45-degree field of view: 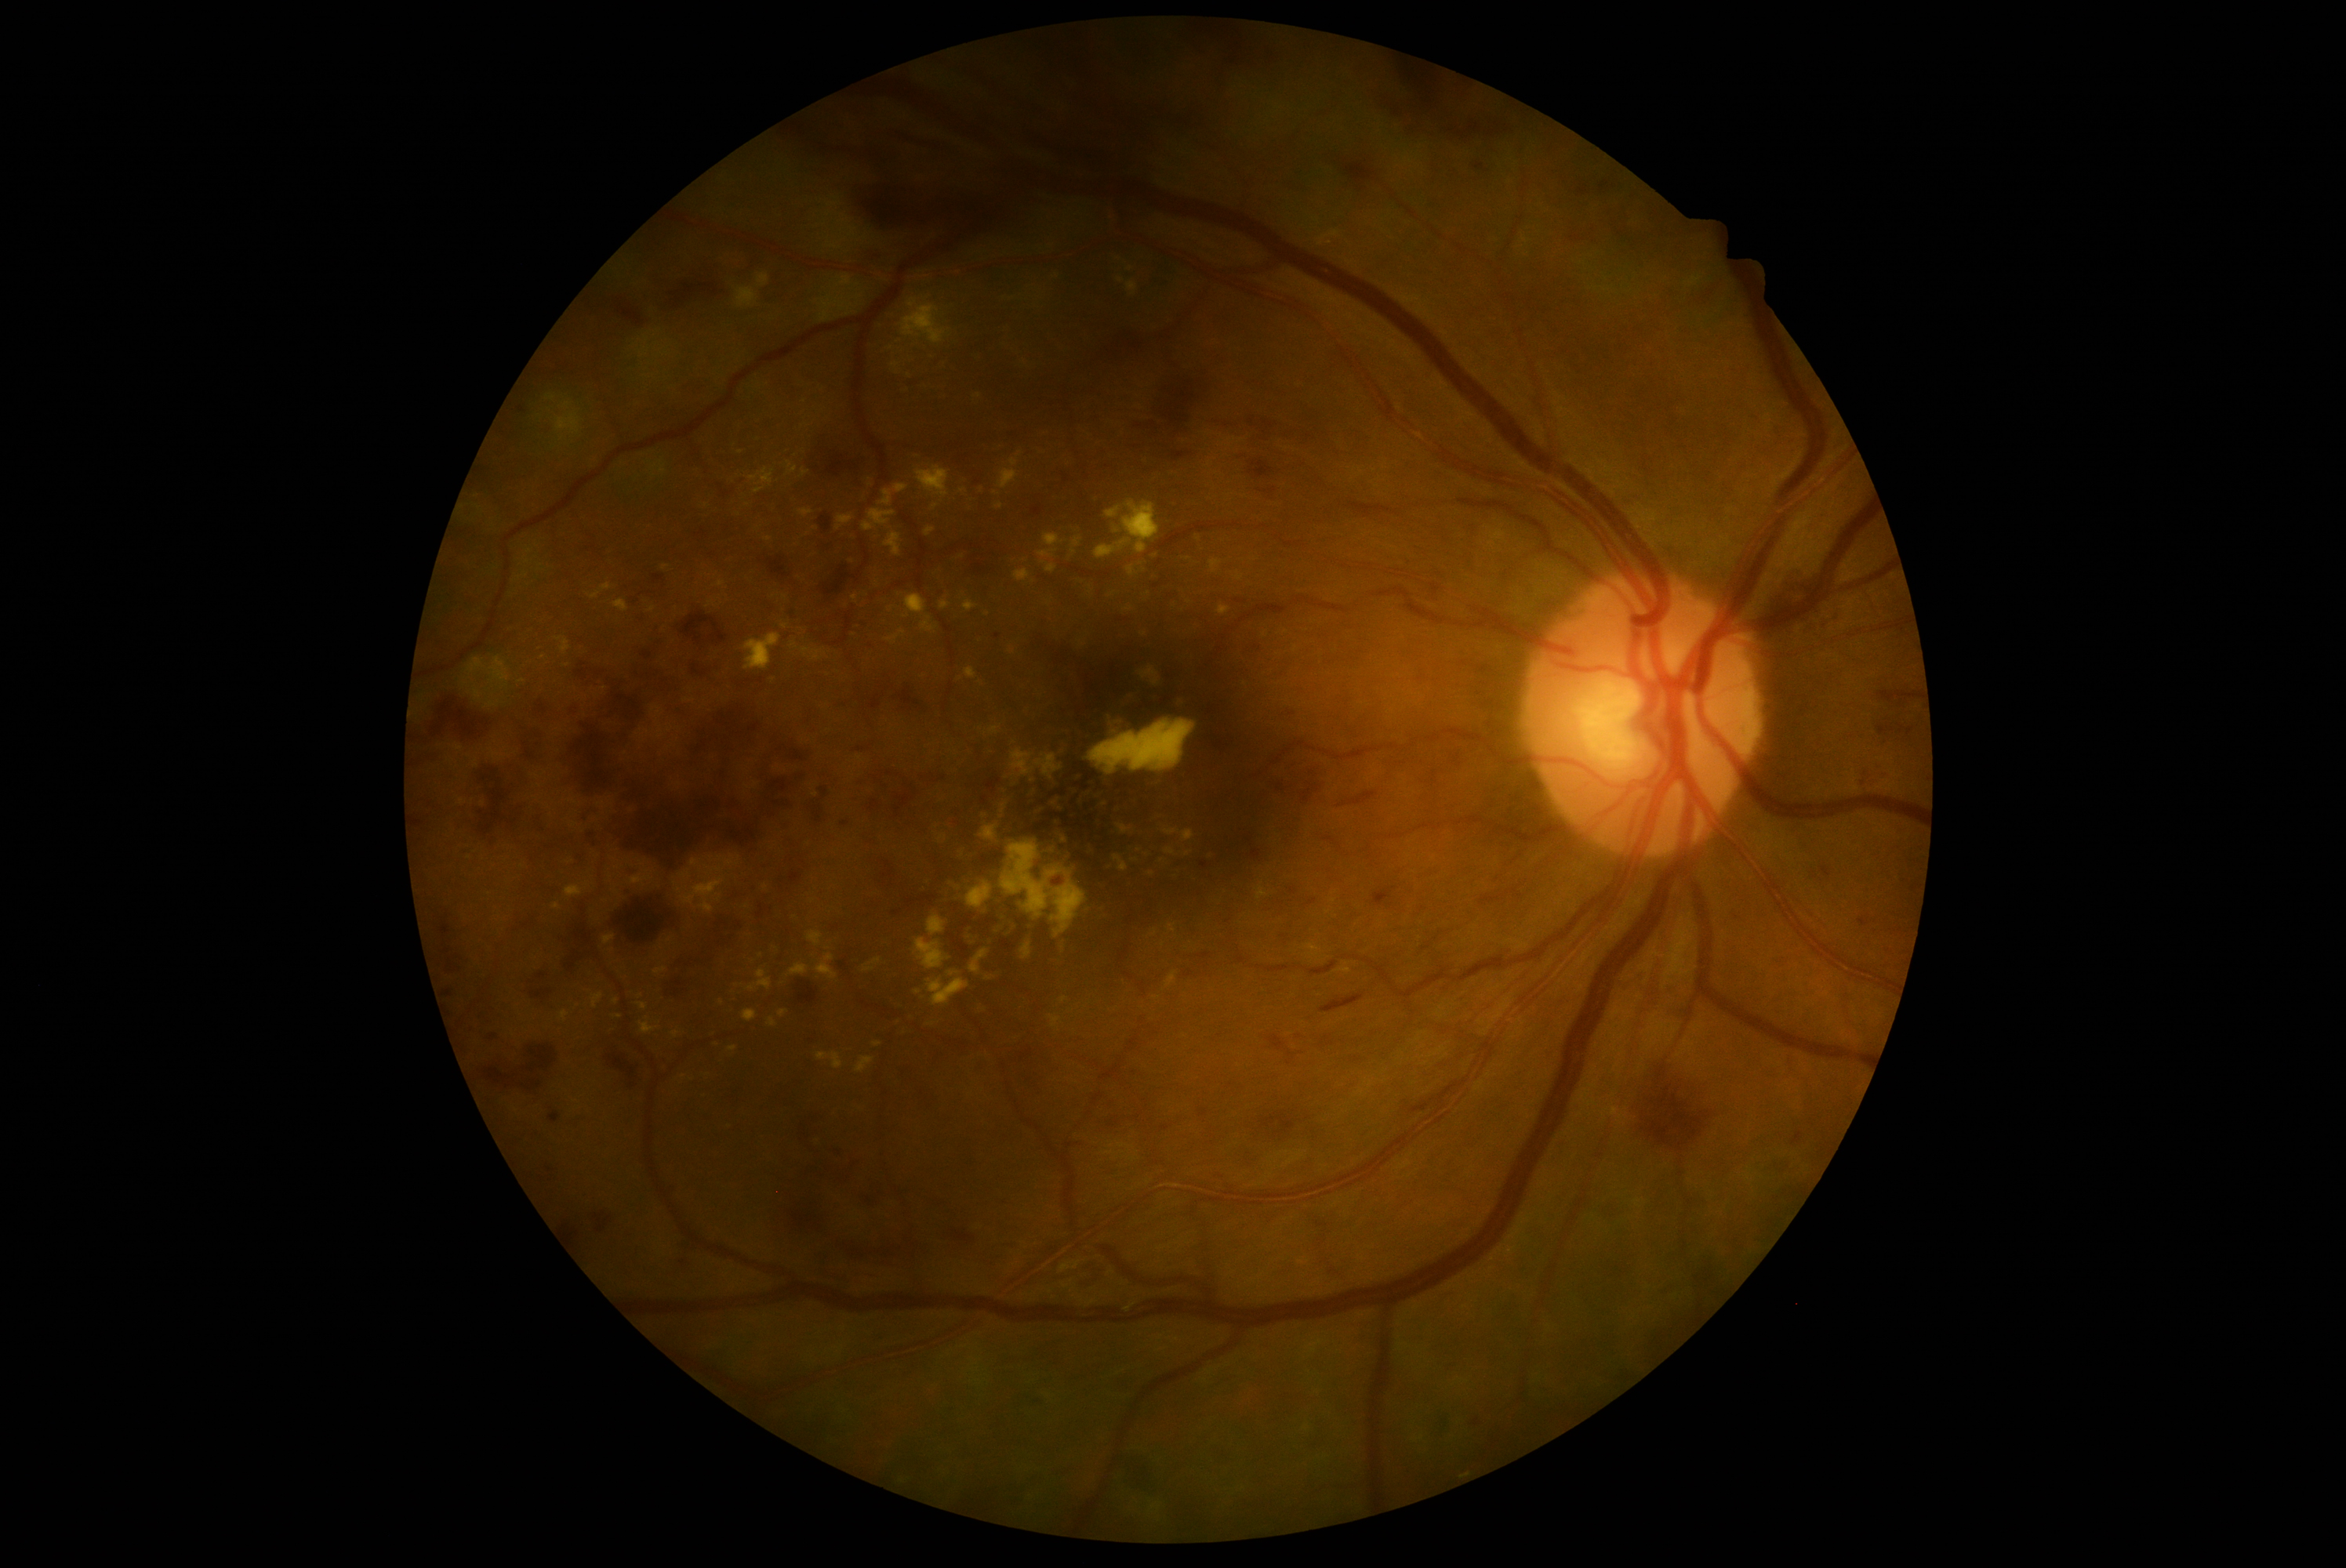
DR is severe non-proliferative diabetic retinopathy (grade 3). DR class: non-proliferative diabetic retinopathy.